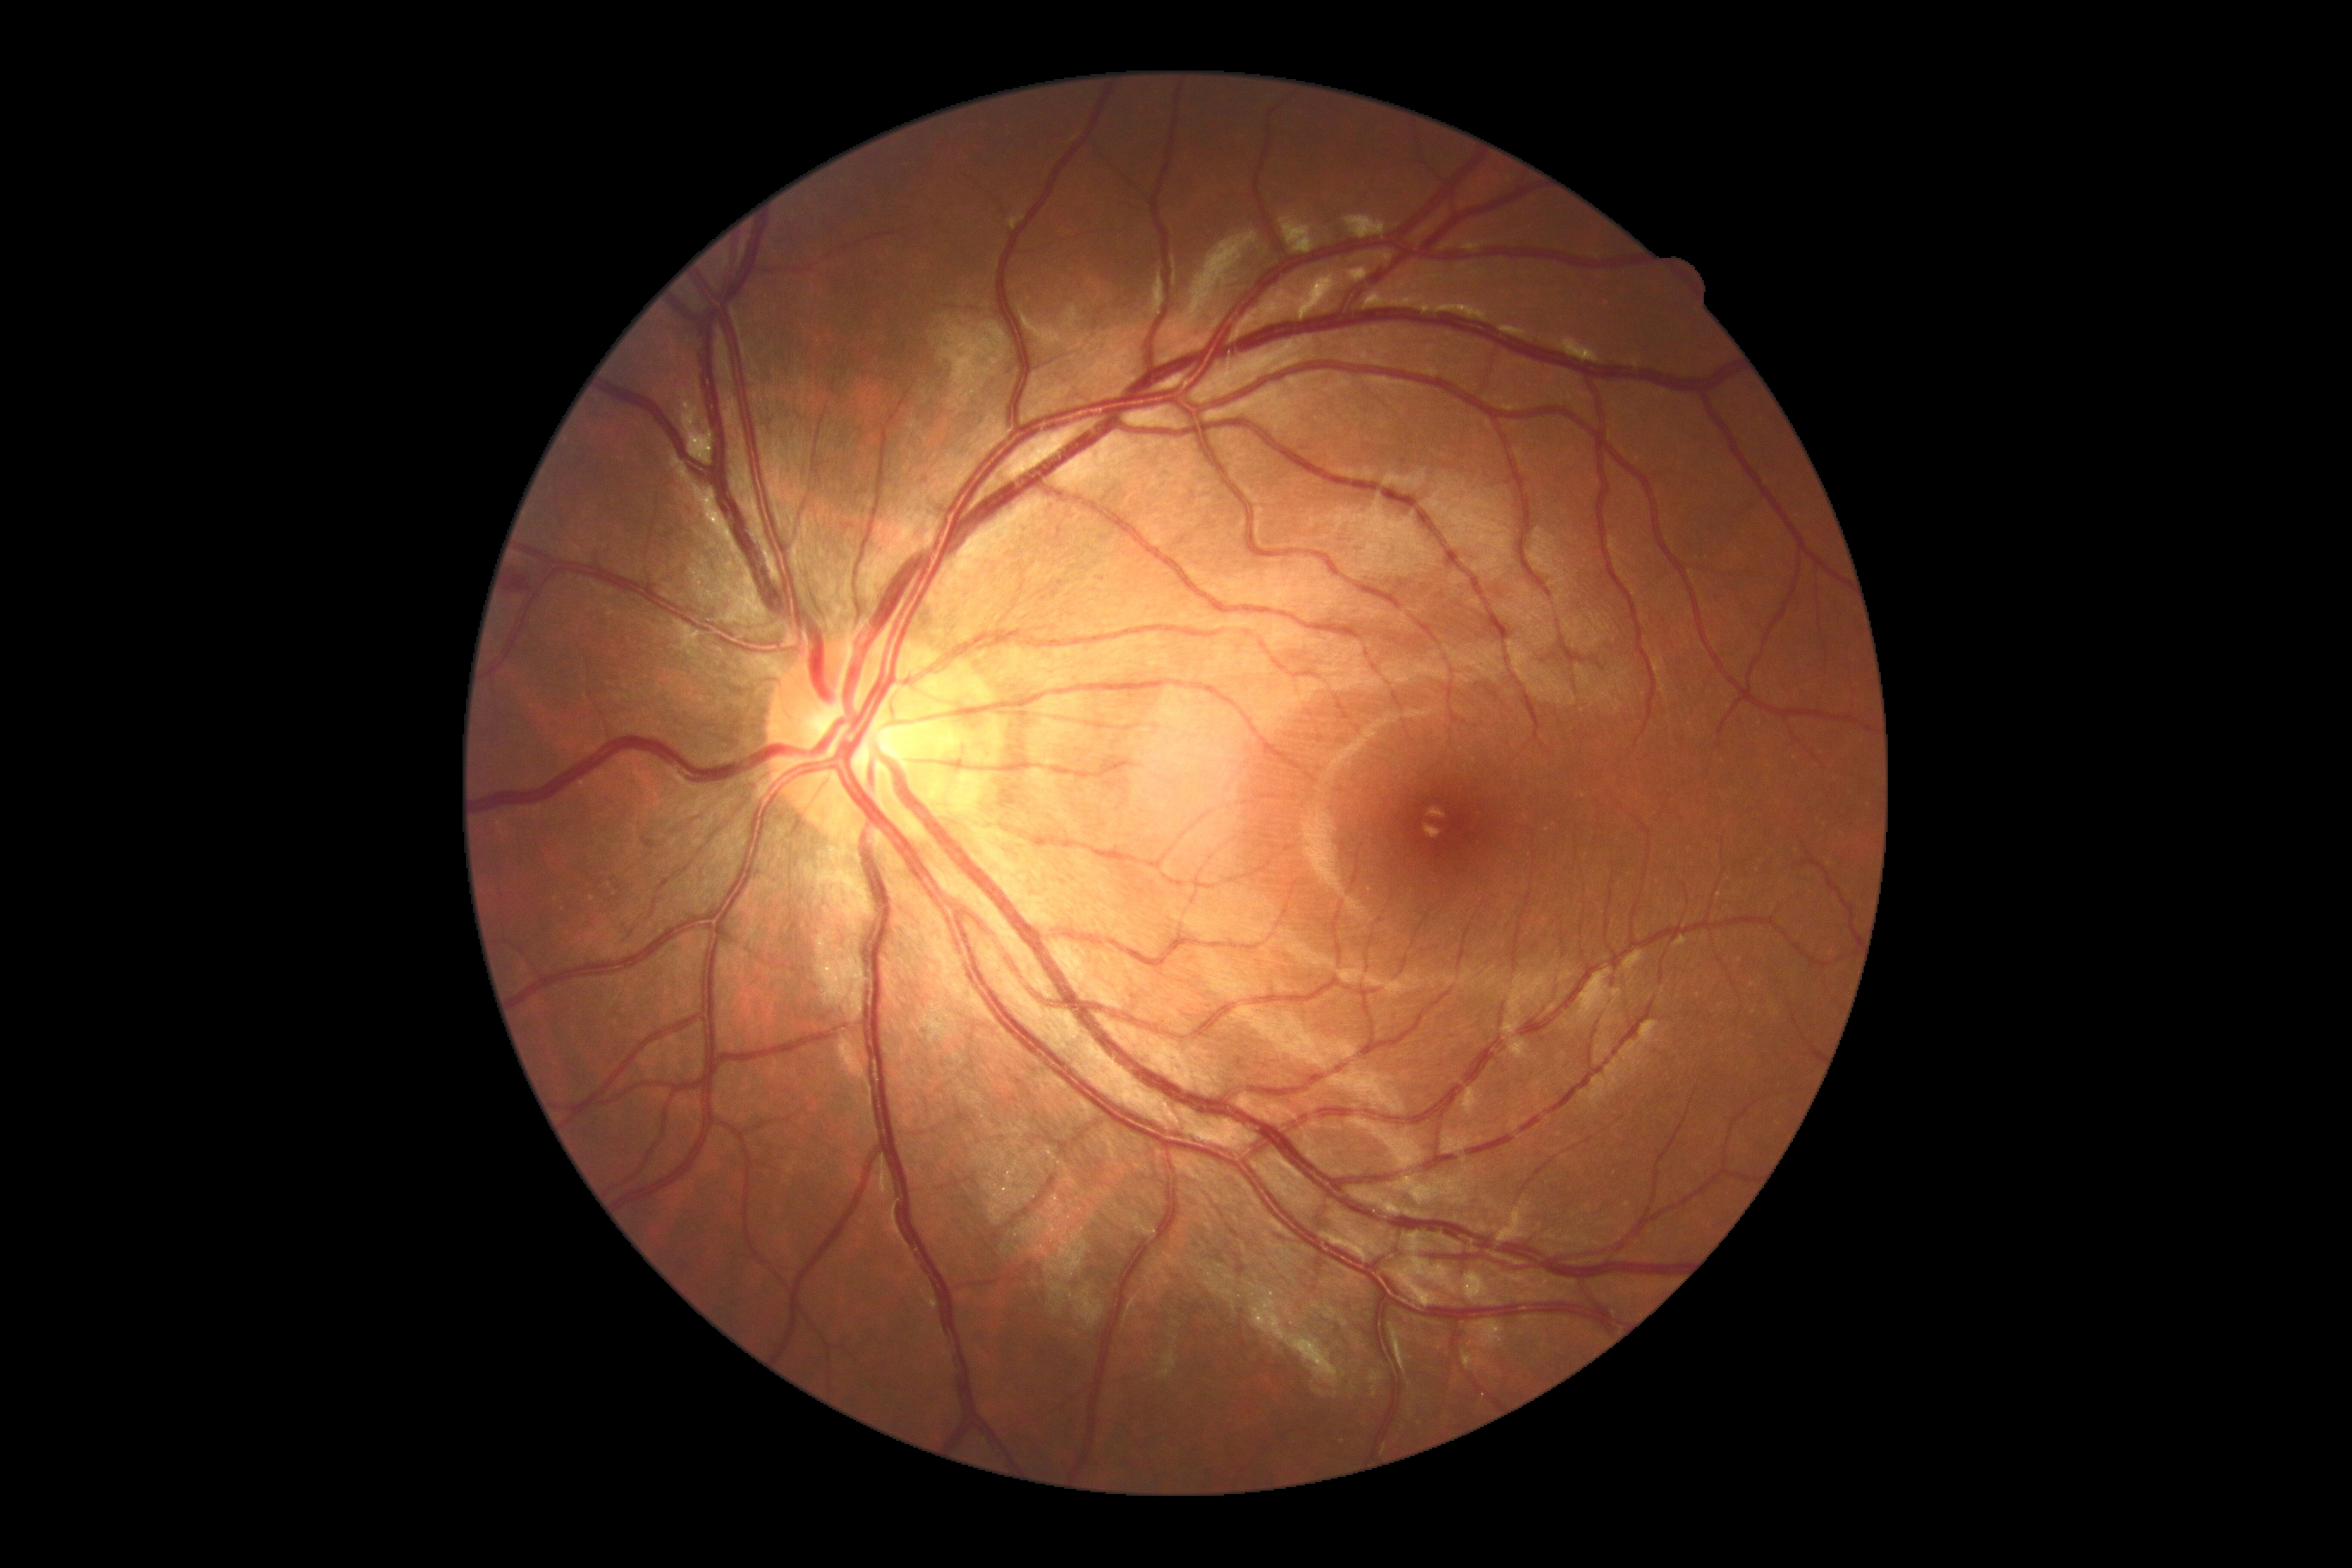
DR severity: moderate NPDR (grade 2).
DR class: non-proliferative diabetic retinopathy.